Wide-field fundus photograph from neonatal ROP screening · image size 1240x1240 — 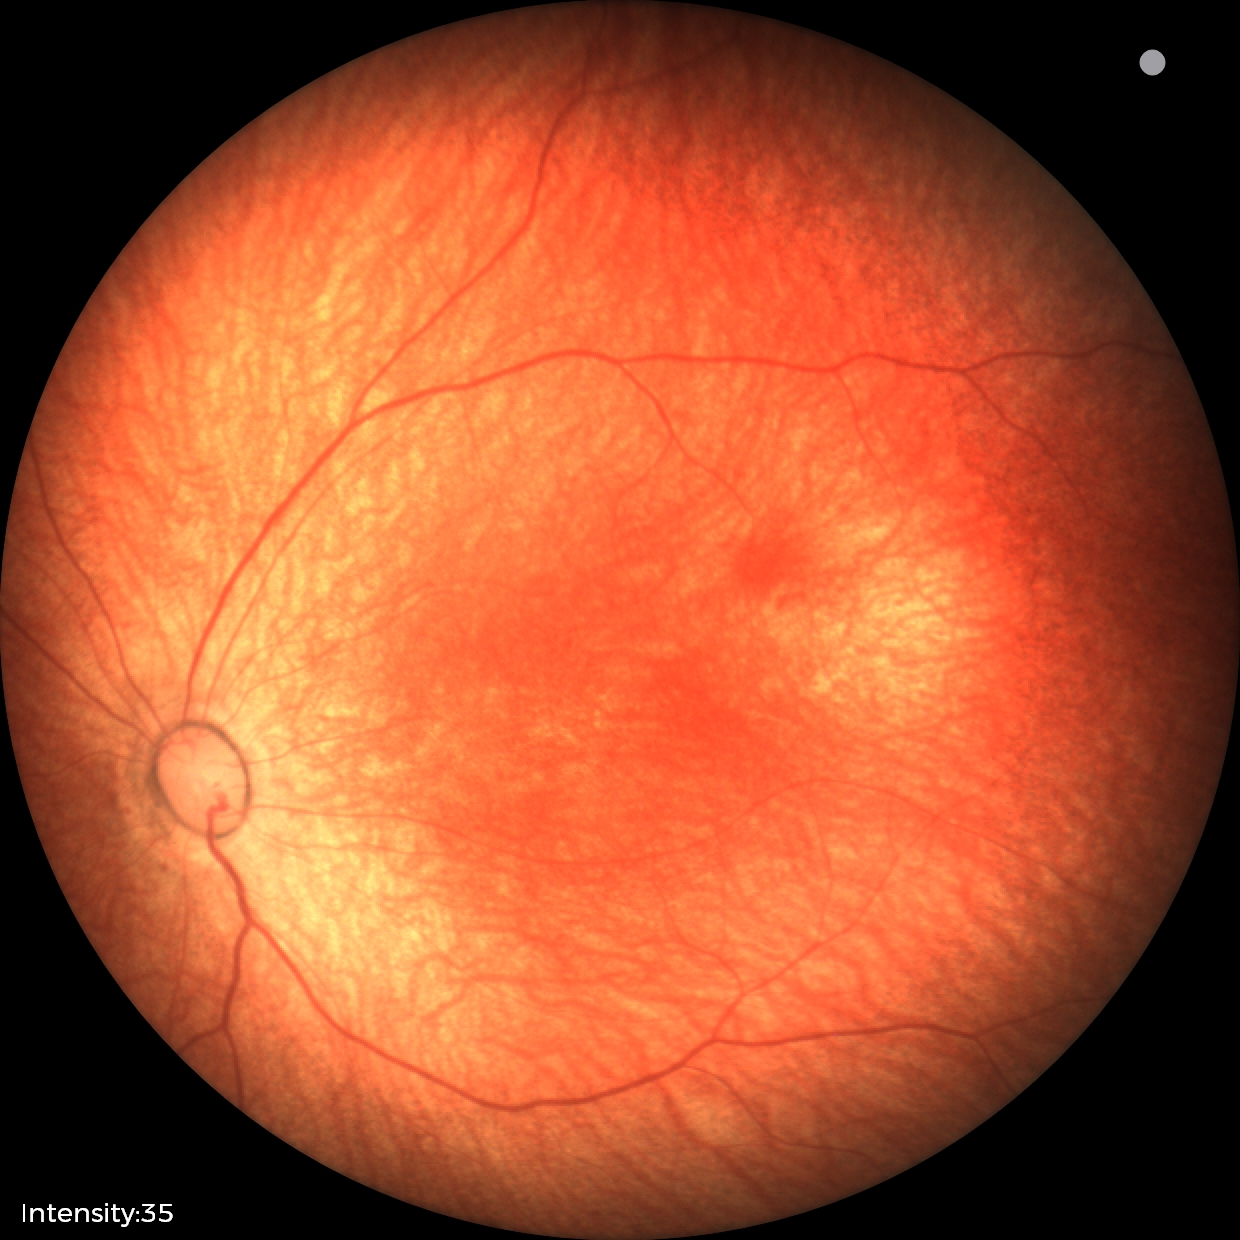 Screening diagnosis: no abnormal retinal findings.